RetCam wide-field infant fundus image. Acquired on the Clarity RetCam 3.
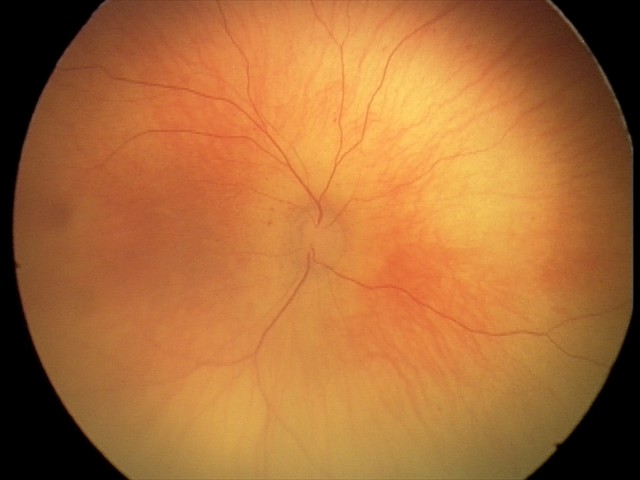 Impression: normal fundus examination.